Graded on the modified Davis scale; 848 by 848 pixels; nonmydriatic:
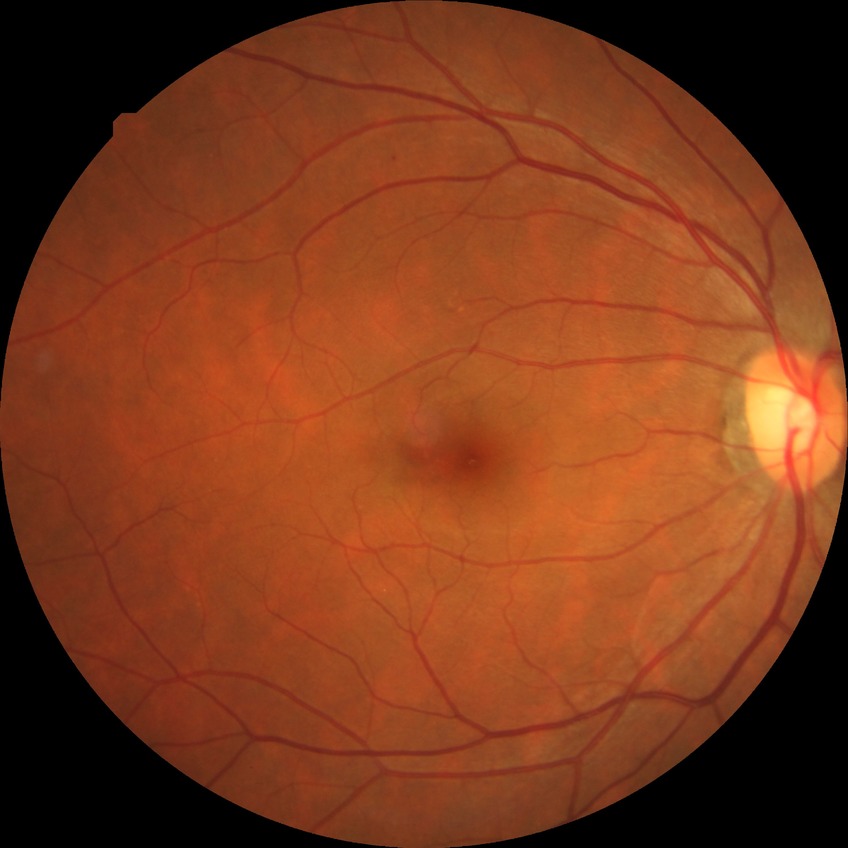
Diabetic retinopathy (DR): no diabetic retinopathy (NDR).